Camera: Phoenix ICON (100° FOV). Wide-field fundus image from infant ROP screening:
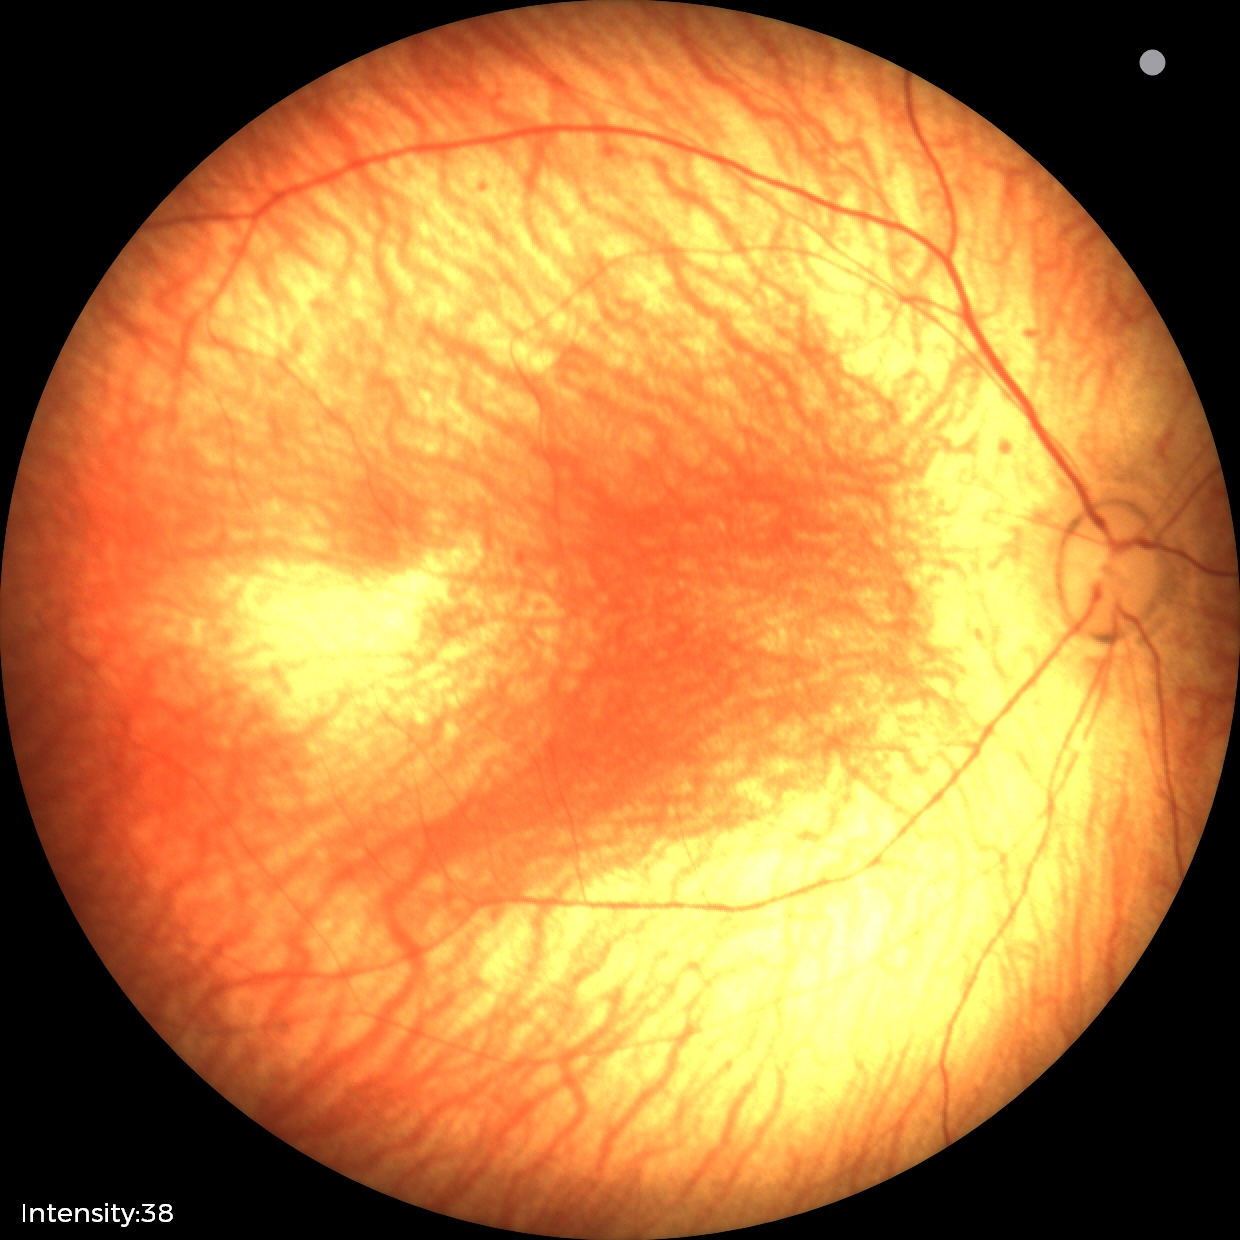

Q: What was the screening finding?
A: normal retinal appearance